Camera: NIDEK AFC-230, no pharmacologic dilation, fundus photo — 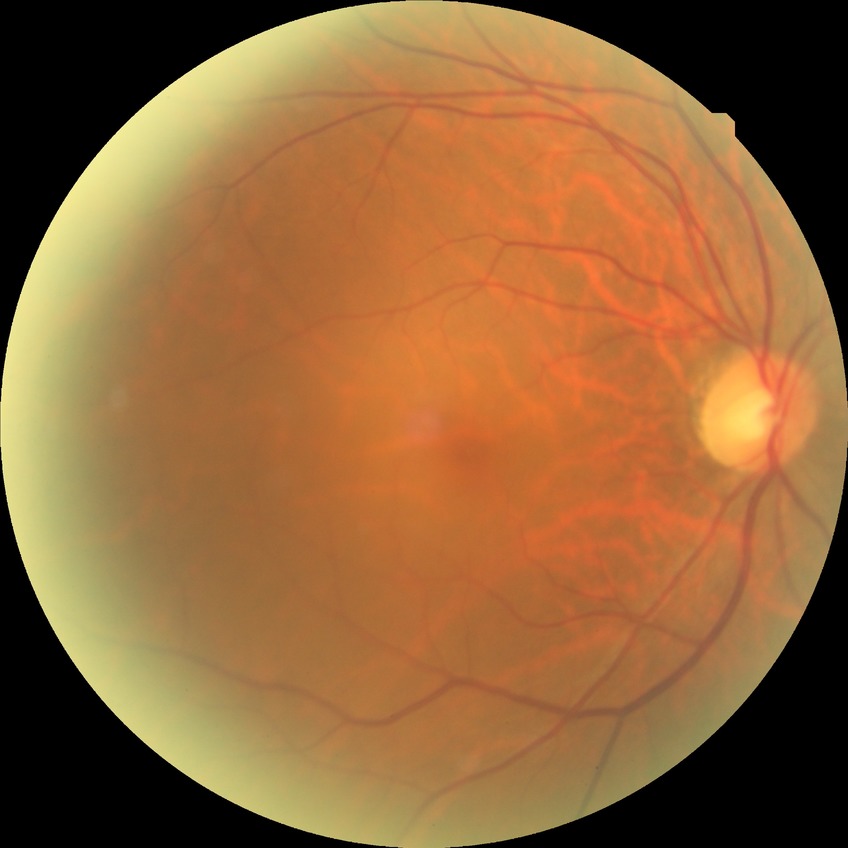 {"davis_grade": "no diabetic retinopathy"}